Camera: NIDEK AFC-230 · posterior pole color fundus photograph · 848 x 848 pixels · DR severity per modified Davis staging · FOV: 45 degrees
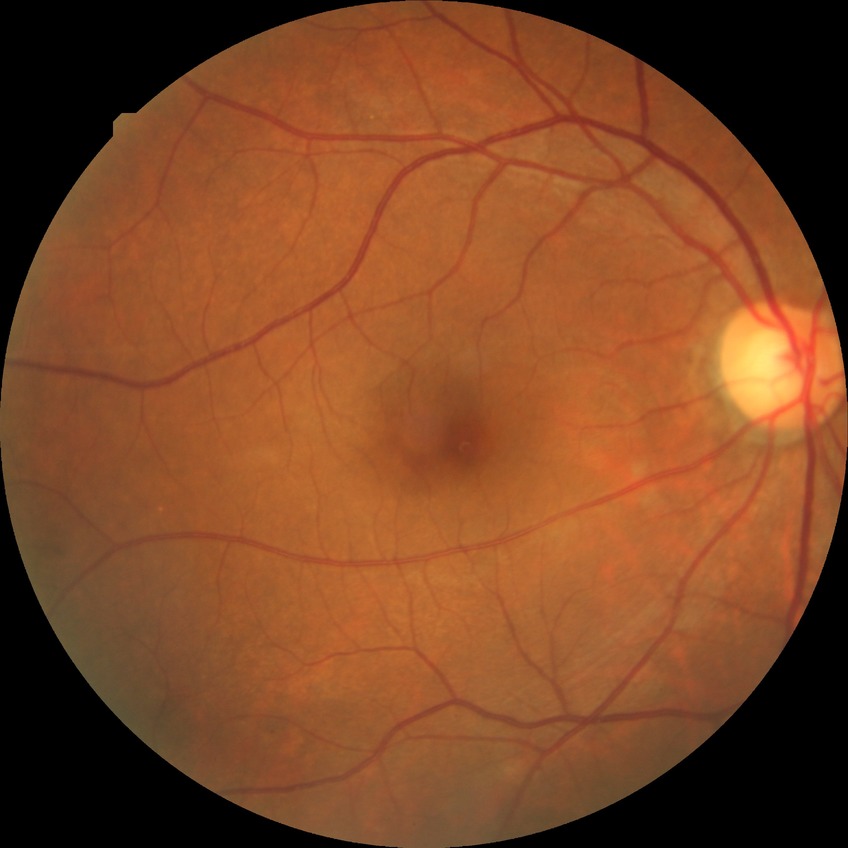 {
  "davis_grade": "simple diabetic retinopathy (SDR)",
  "proliferative_class": "non-proliferative diabetic retinopathy"
}